45-degree field of view · fundus photo · 1932 x 1932 pixels:
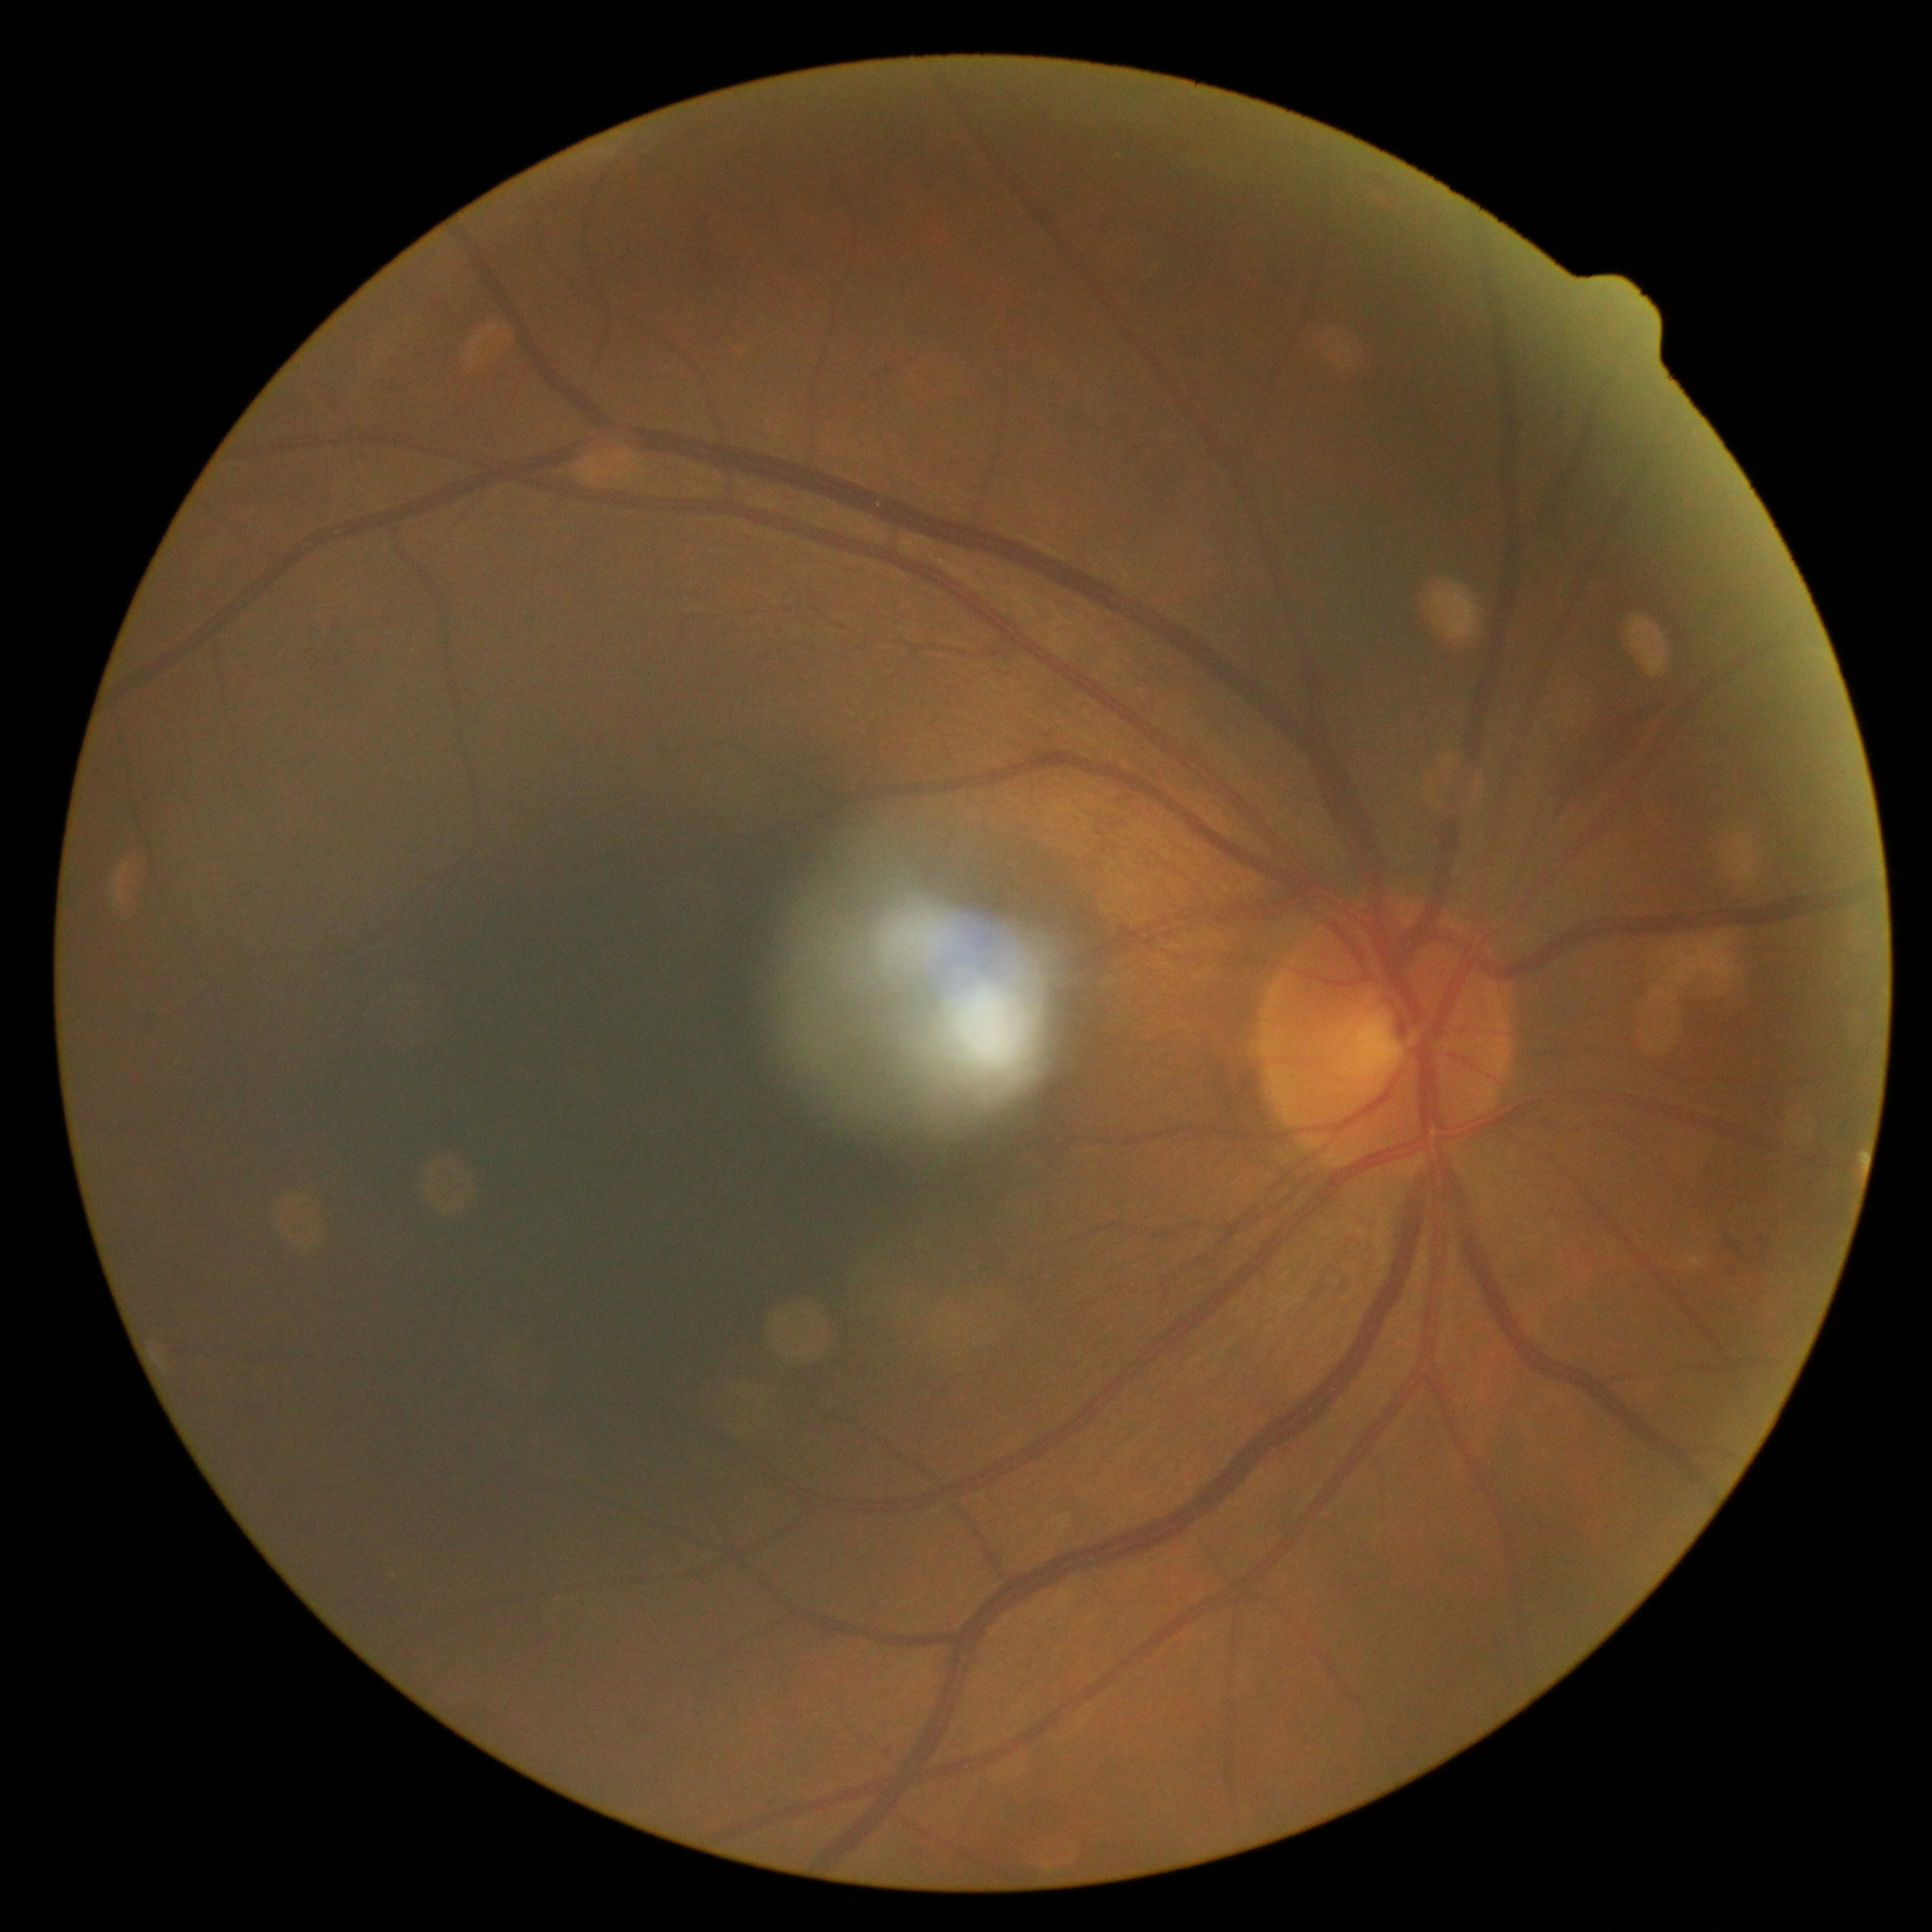
DR severity = grade 2 (moderate NPDR).